Phoenix ICON wide-field infant fundus image. 1240 x 1240 pixels — 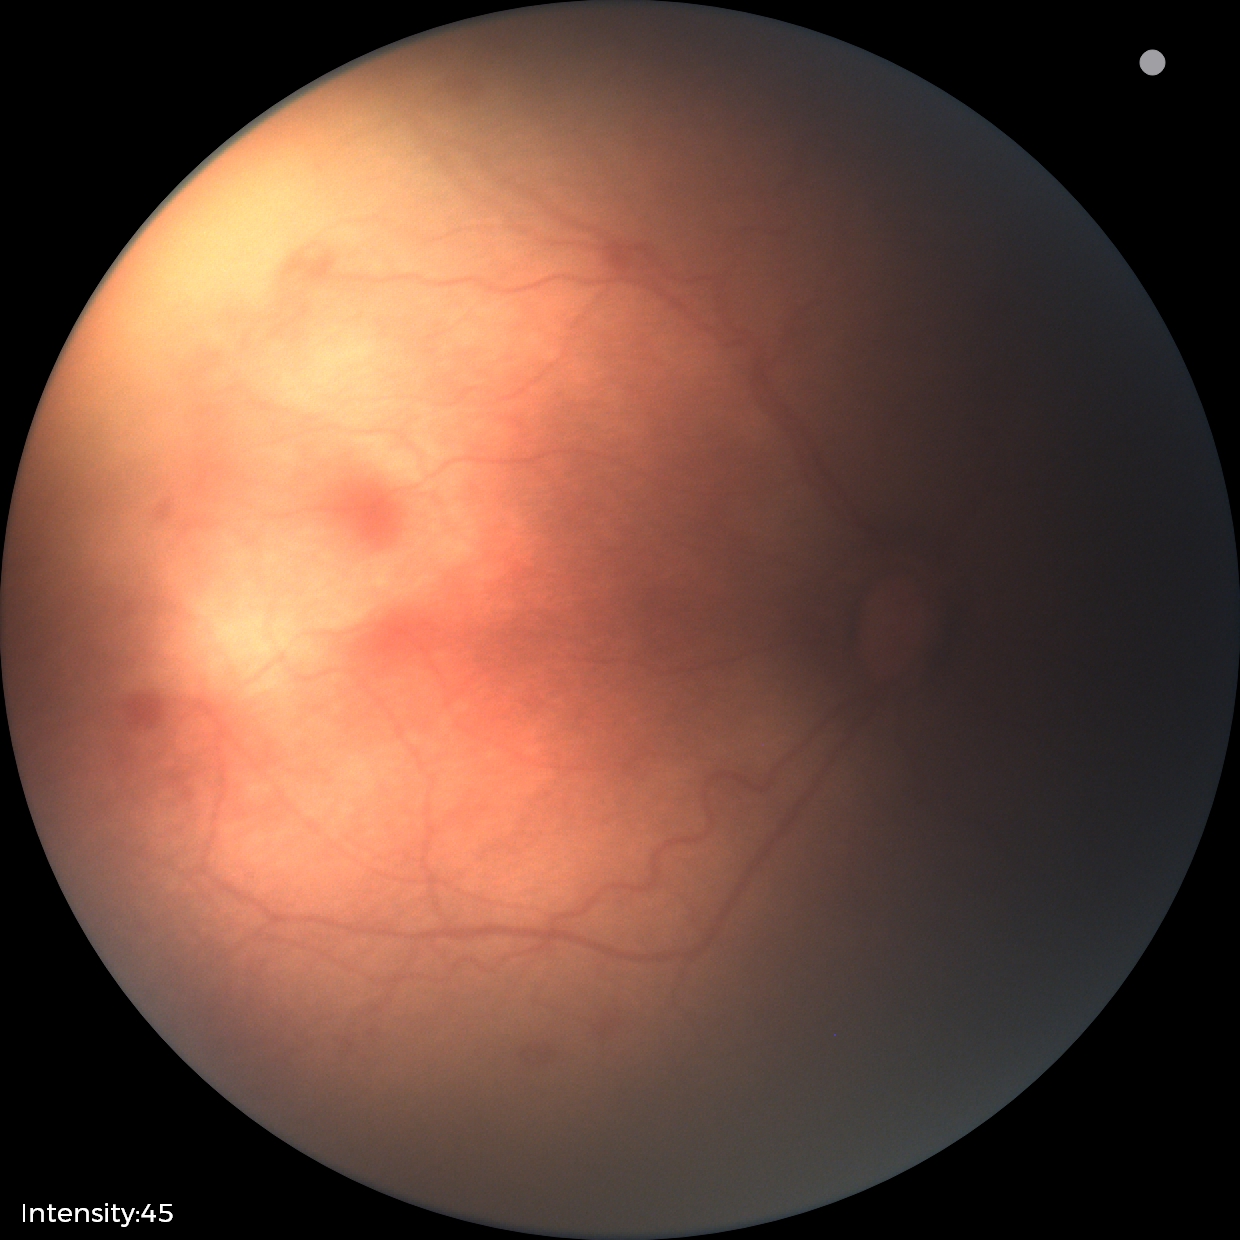 No plus disease. From an examination with diagnosis of retinopathy of prematurity stage 1.